Davis DR grading:
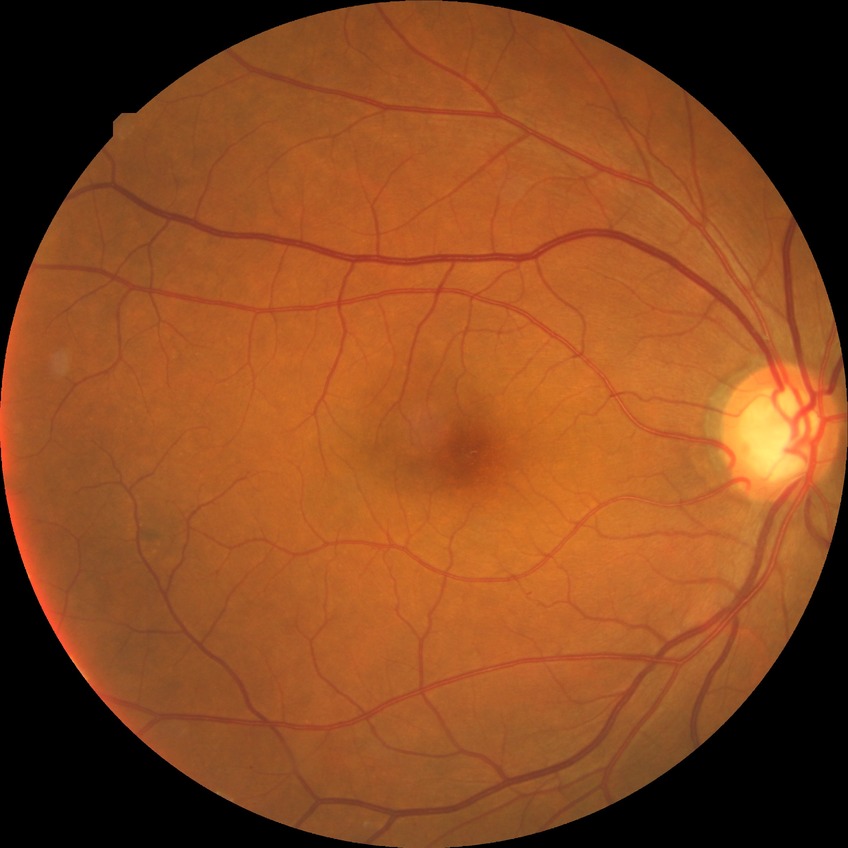
{"davis_grade": "NDR (no diabetic retinopathy)"}